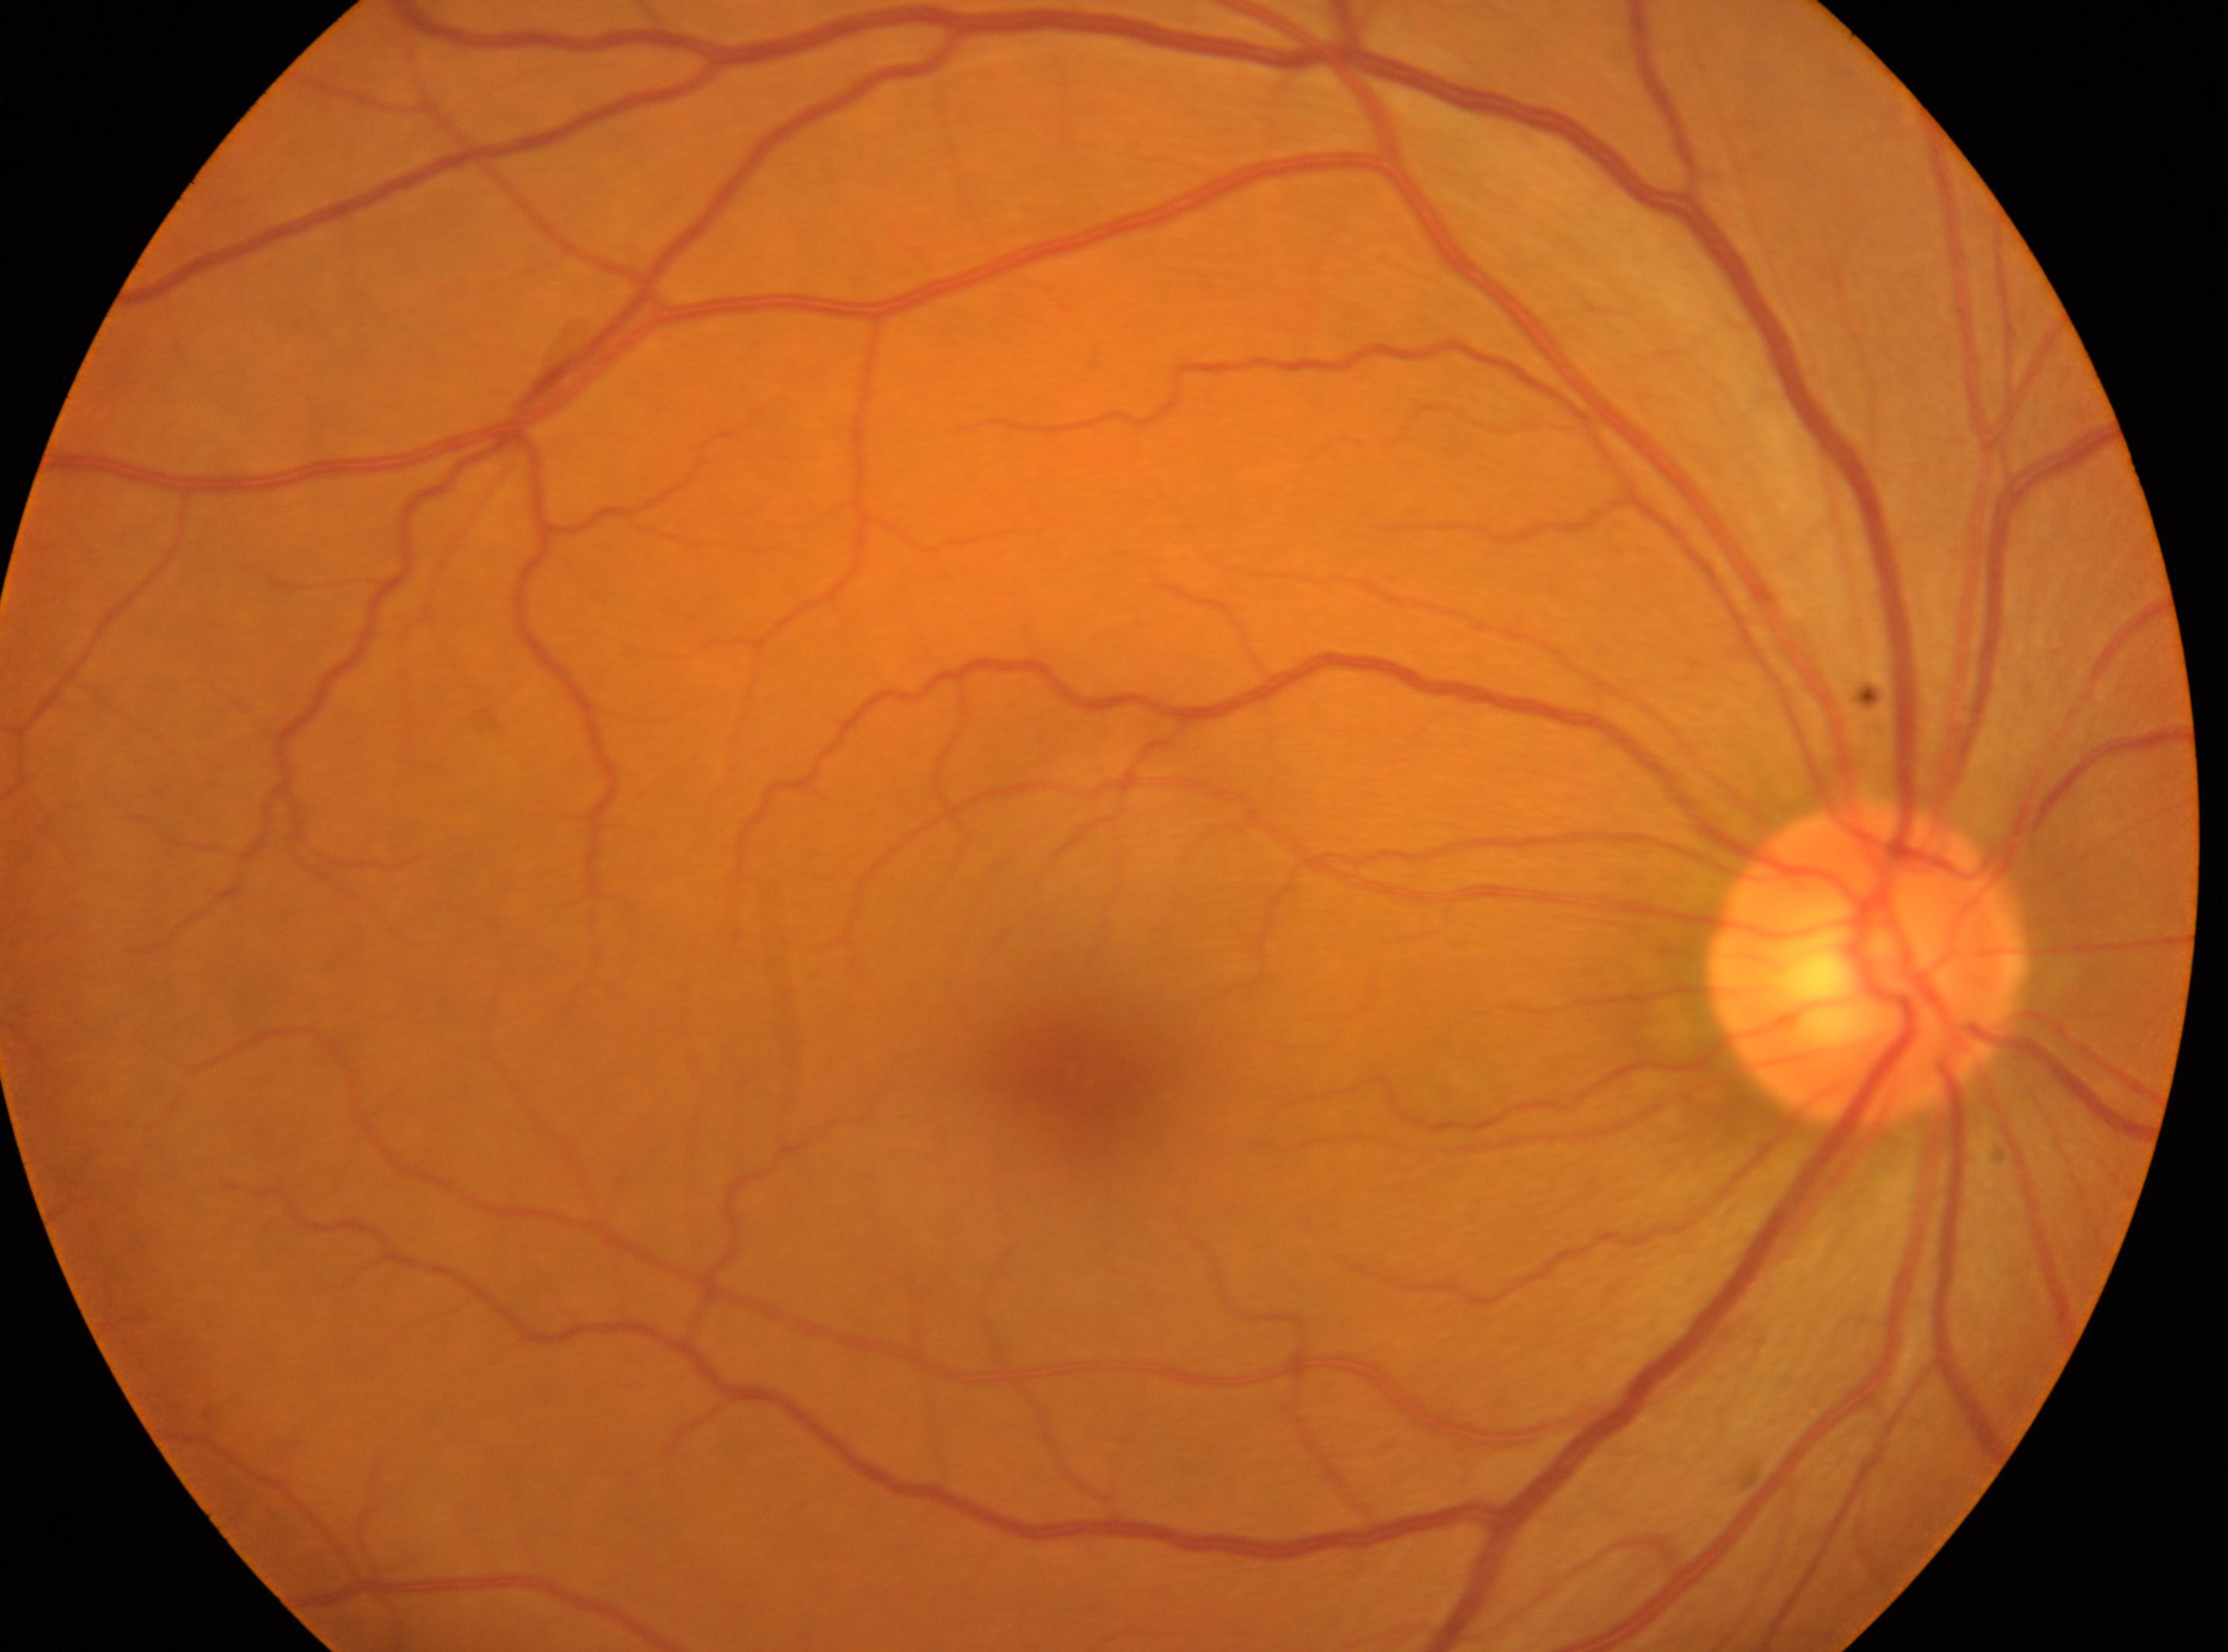
| feature | annotation |
|---|---|
| optic disc | [1869, 965] |
| laterality | oculus dexter |
| foveal center | [1082, 1073] |
| DR grade | no apparent diabetic retinopathy (0) |